45 degree fundus photograph; acquired with a NIDEK AFC-230; image size 848x848; without pupil dilation
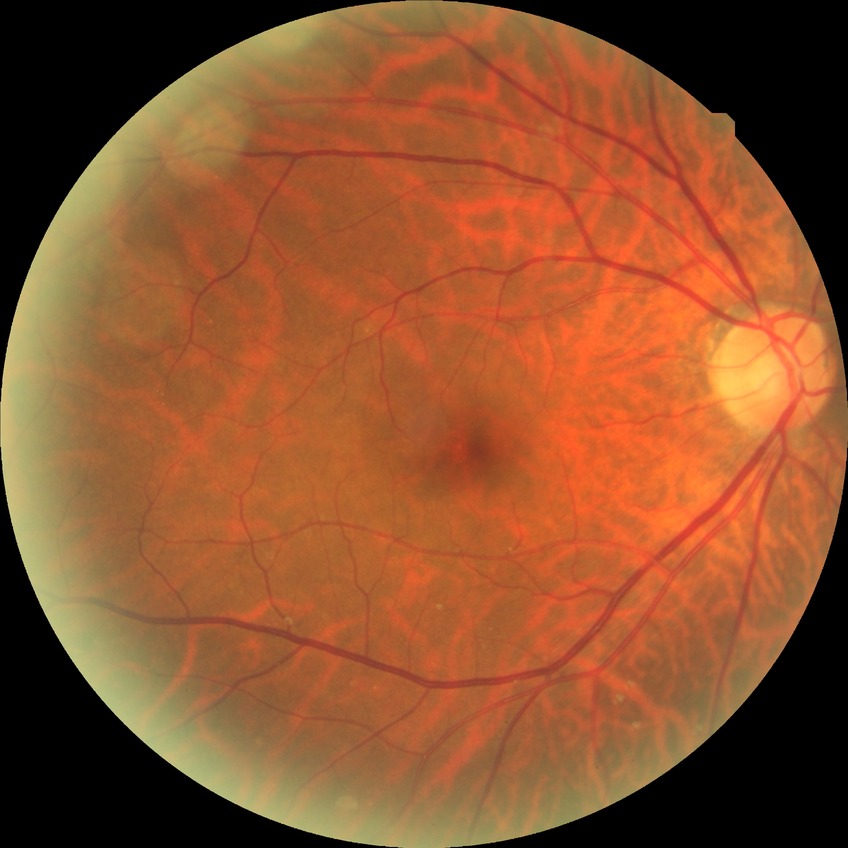 Retinopathy grade is no diabetic retinopathy.